Without pupil dilation; NIDEK AFC-230; modified Davis classification; 848 by 848 pixels: 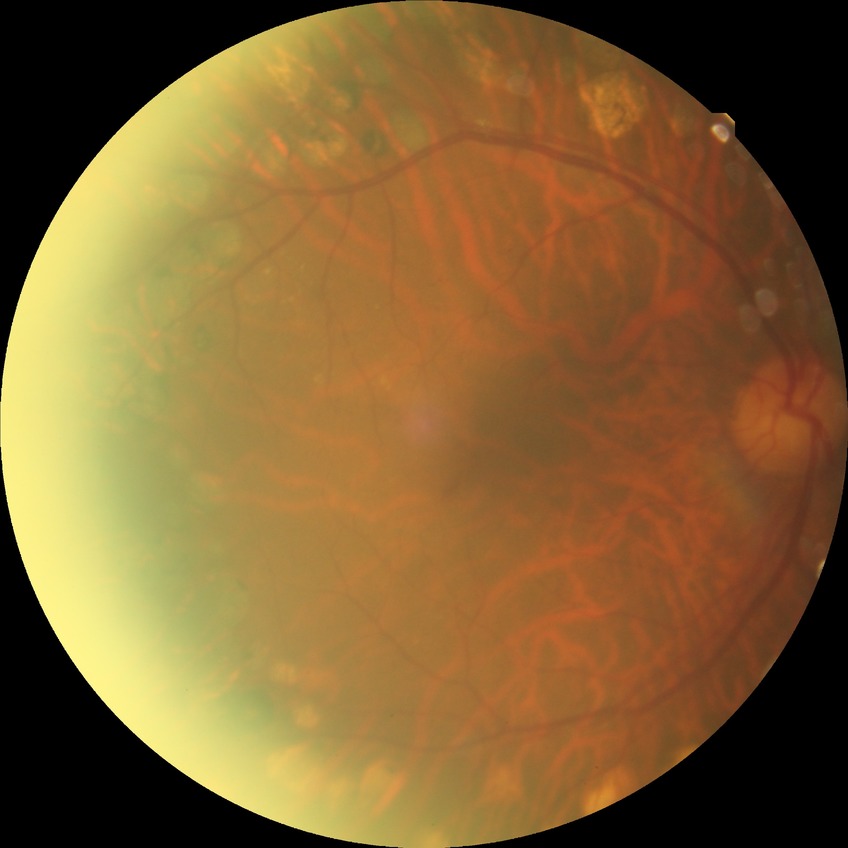
Diabetic retinopathy (DR) is PDR (proliferative diabetic retinopathy).